Without pupil dilation.
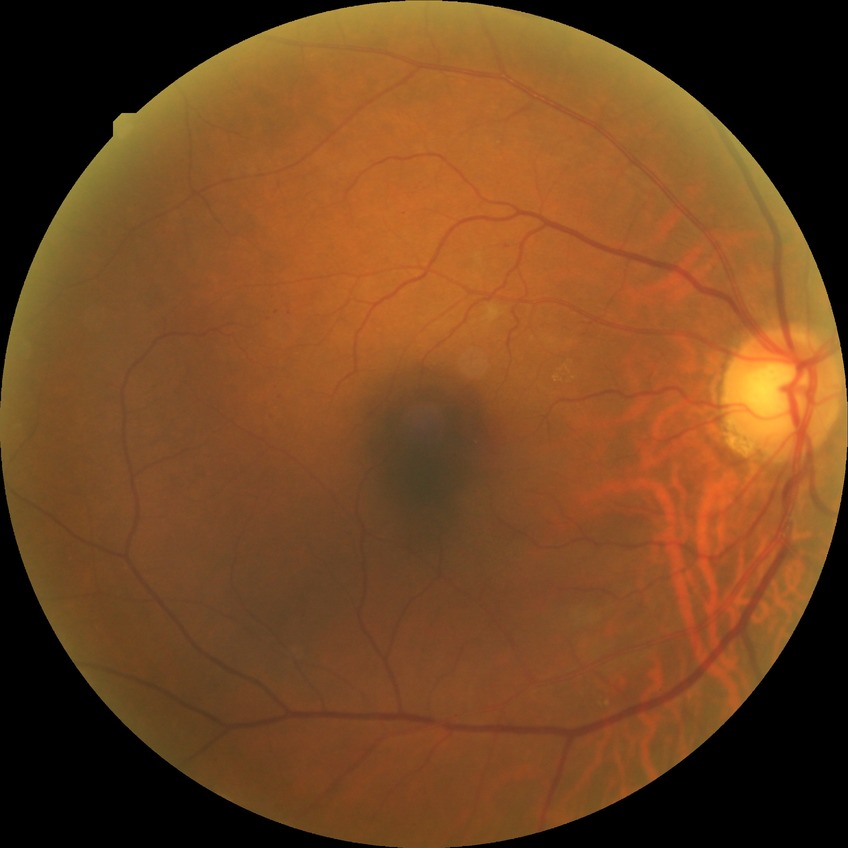
Diabetic retinopathy (DR) is simple diabetic retinopathy (SDR).